60° FOV; 2212 by 1659 pixels; handheld portable fundus camera image: 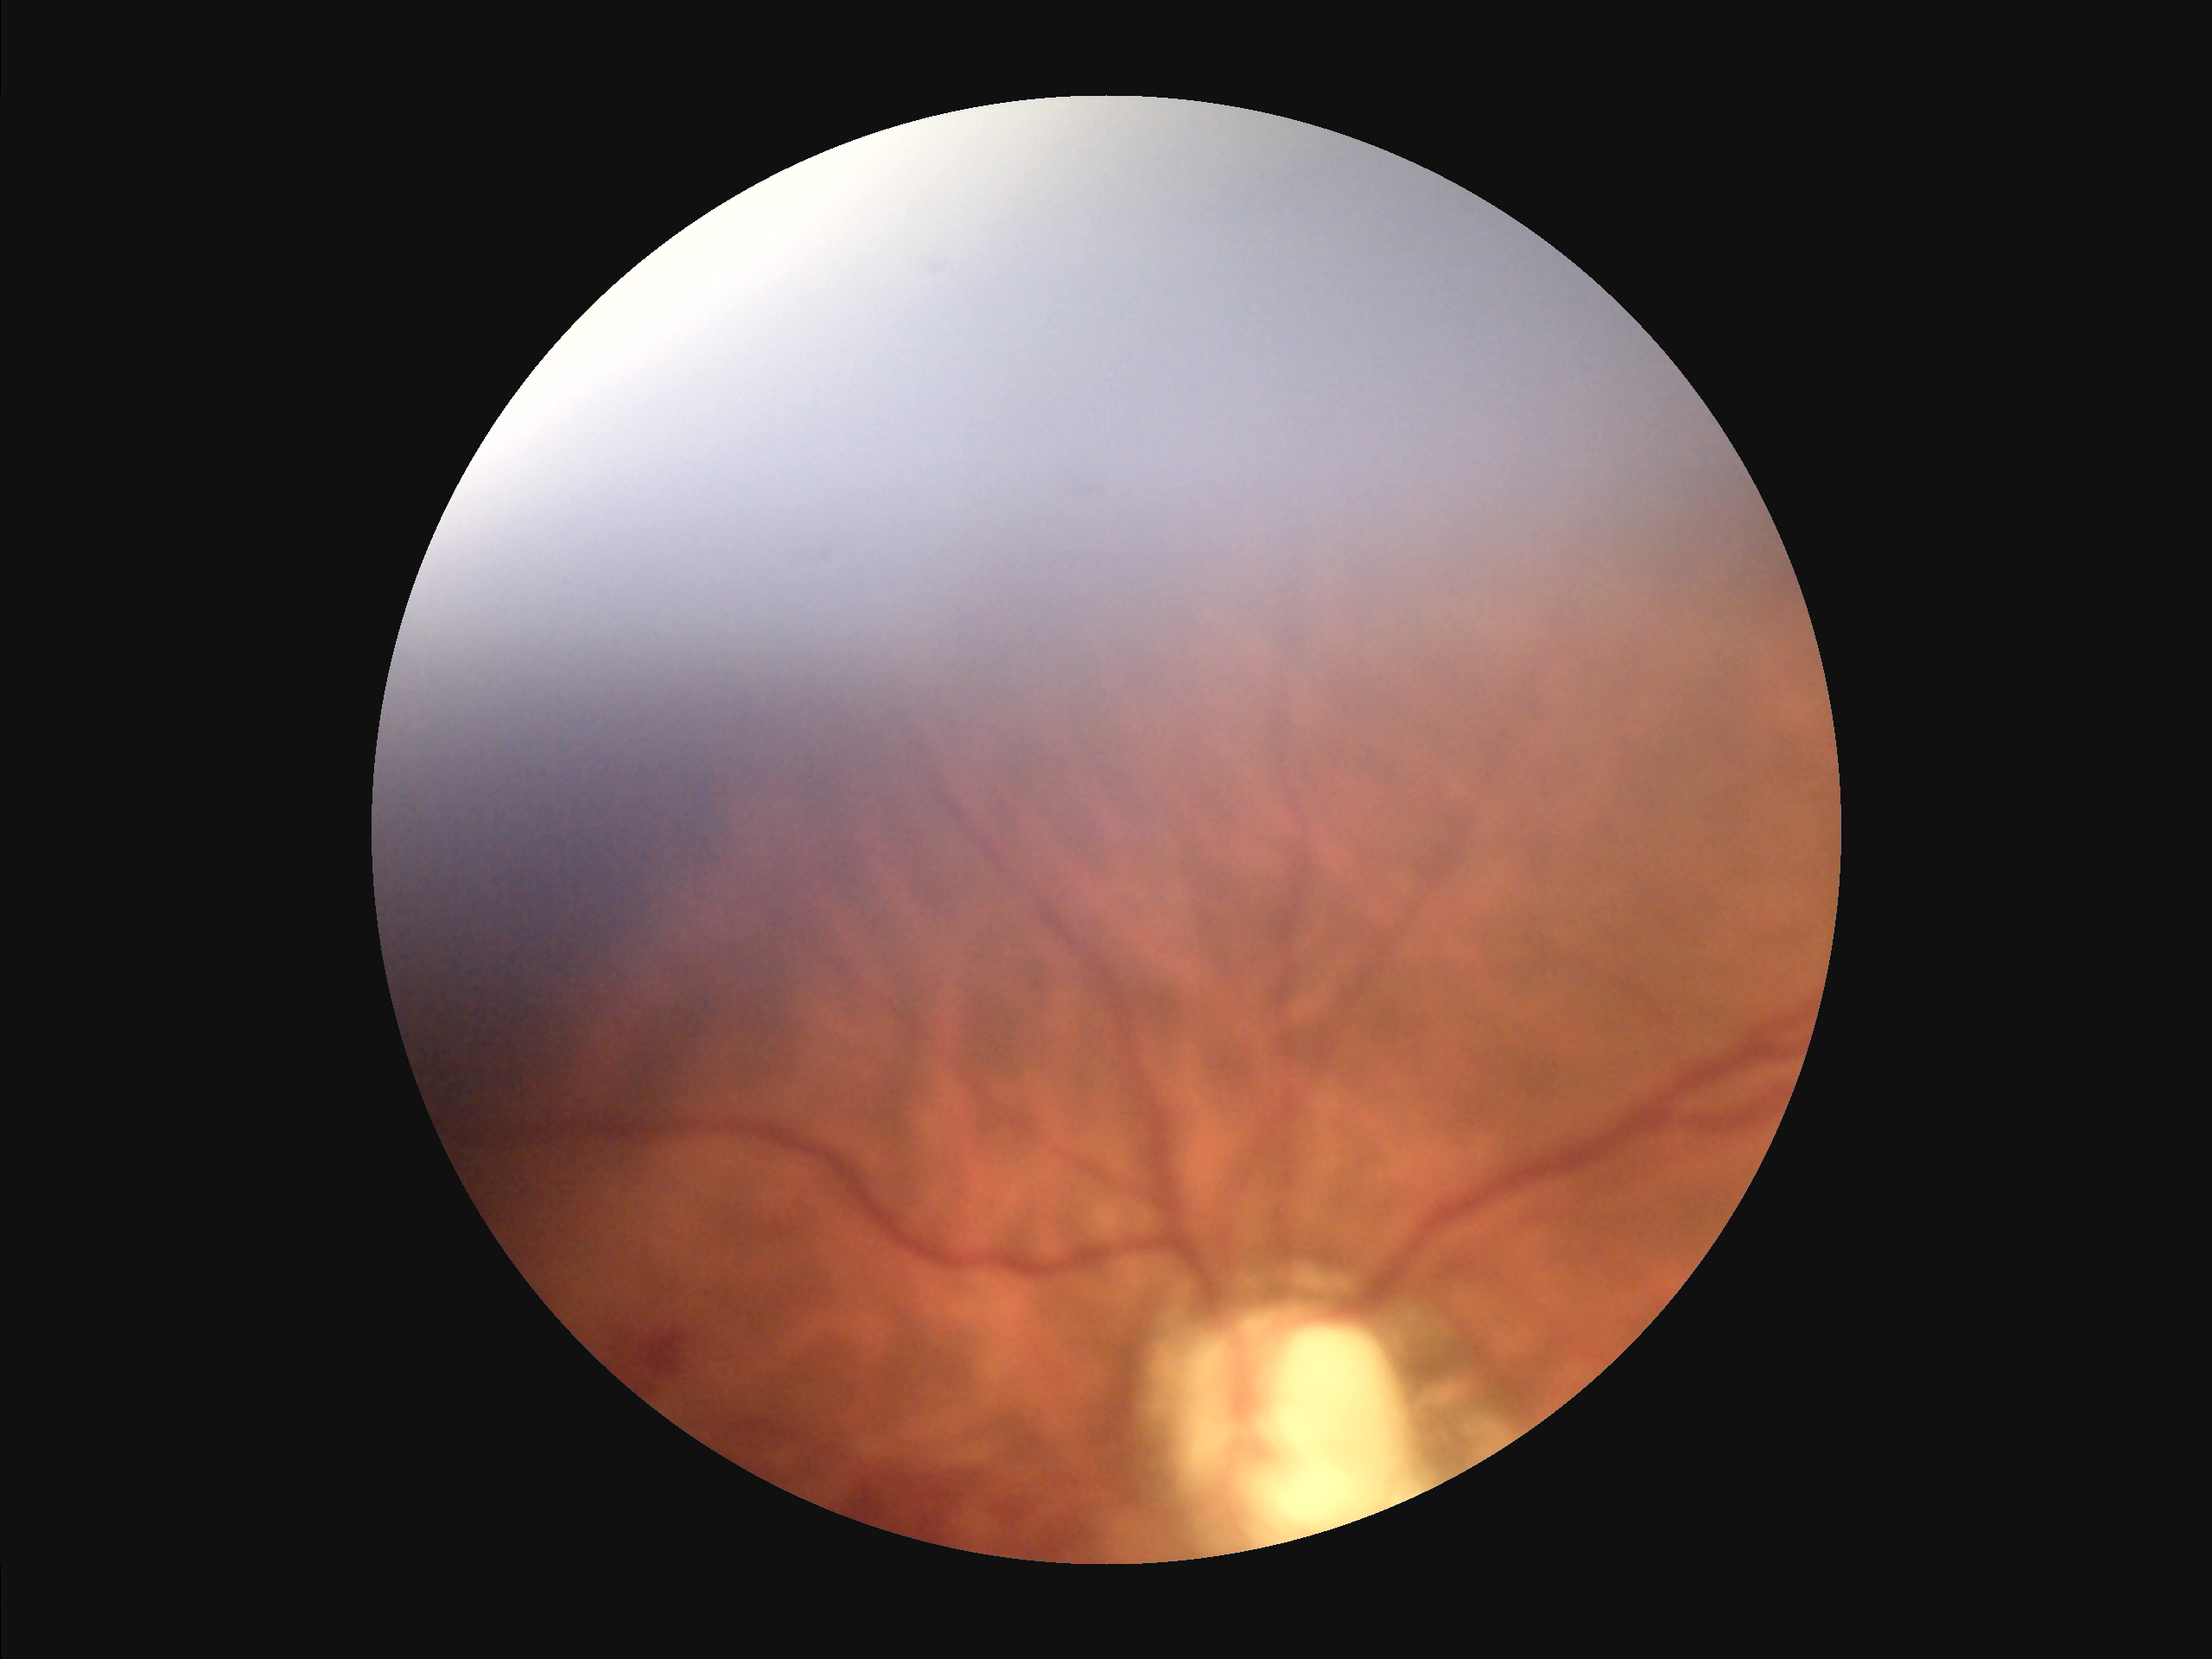 Illumination is uneven. Out of focus; structures are indistinct. Image quality is suboptimal. Vessels and details are readily distinguishable.